Image size 2352x1568 — 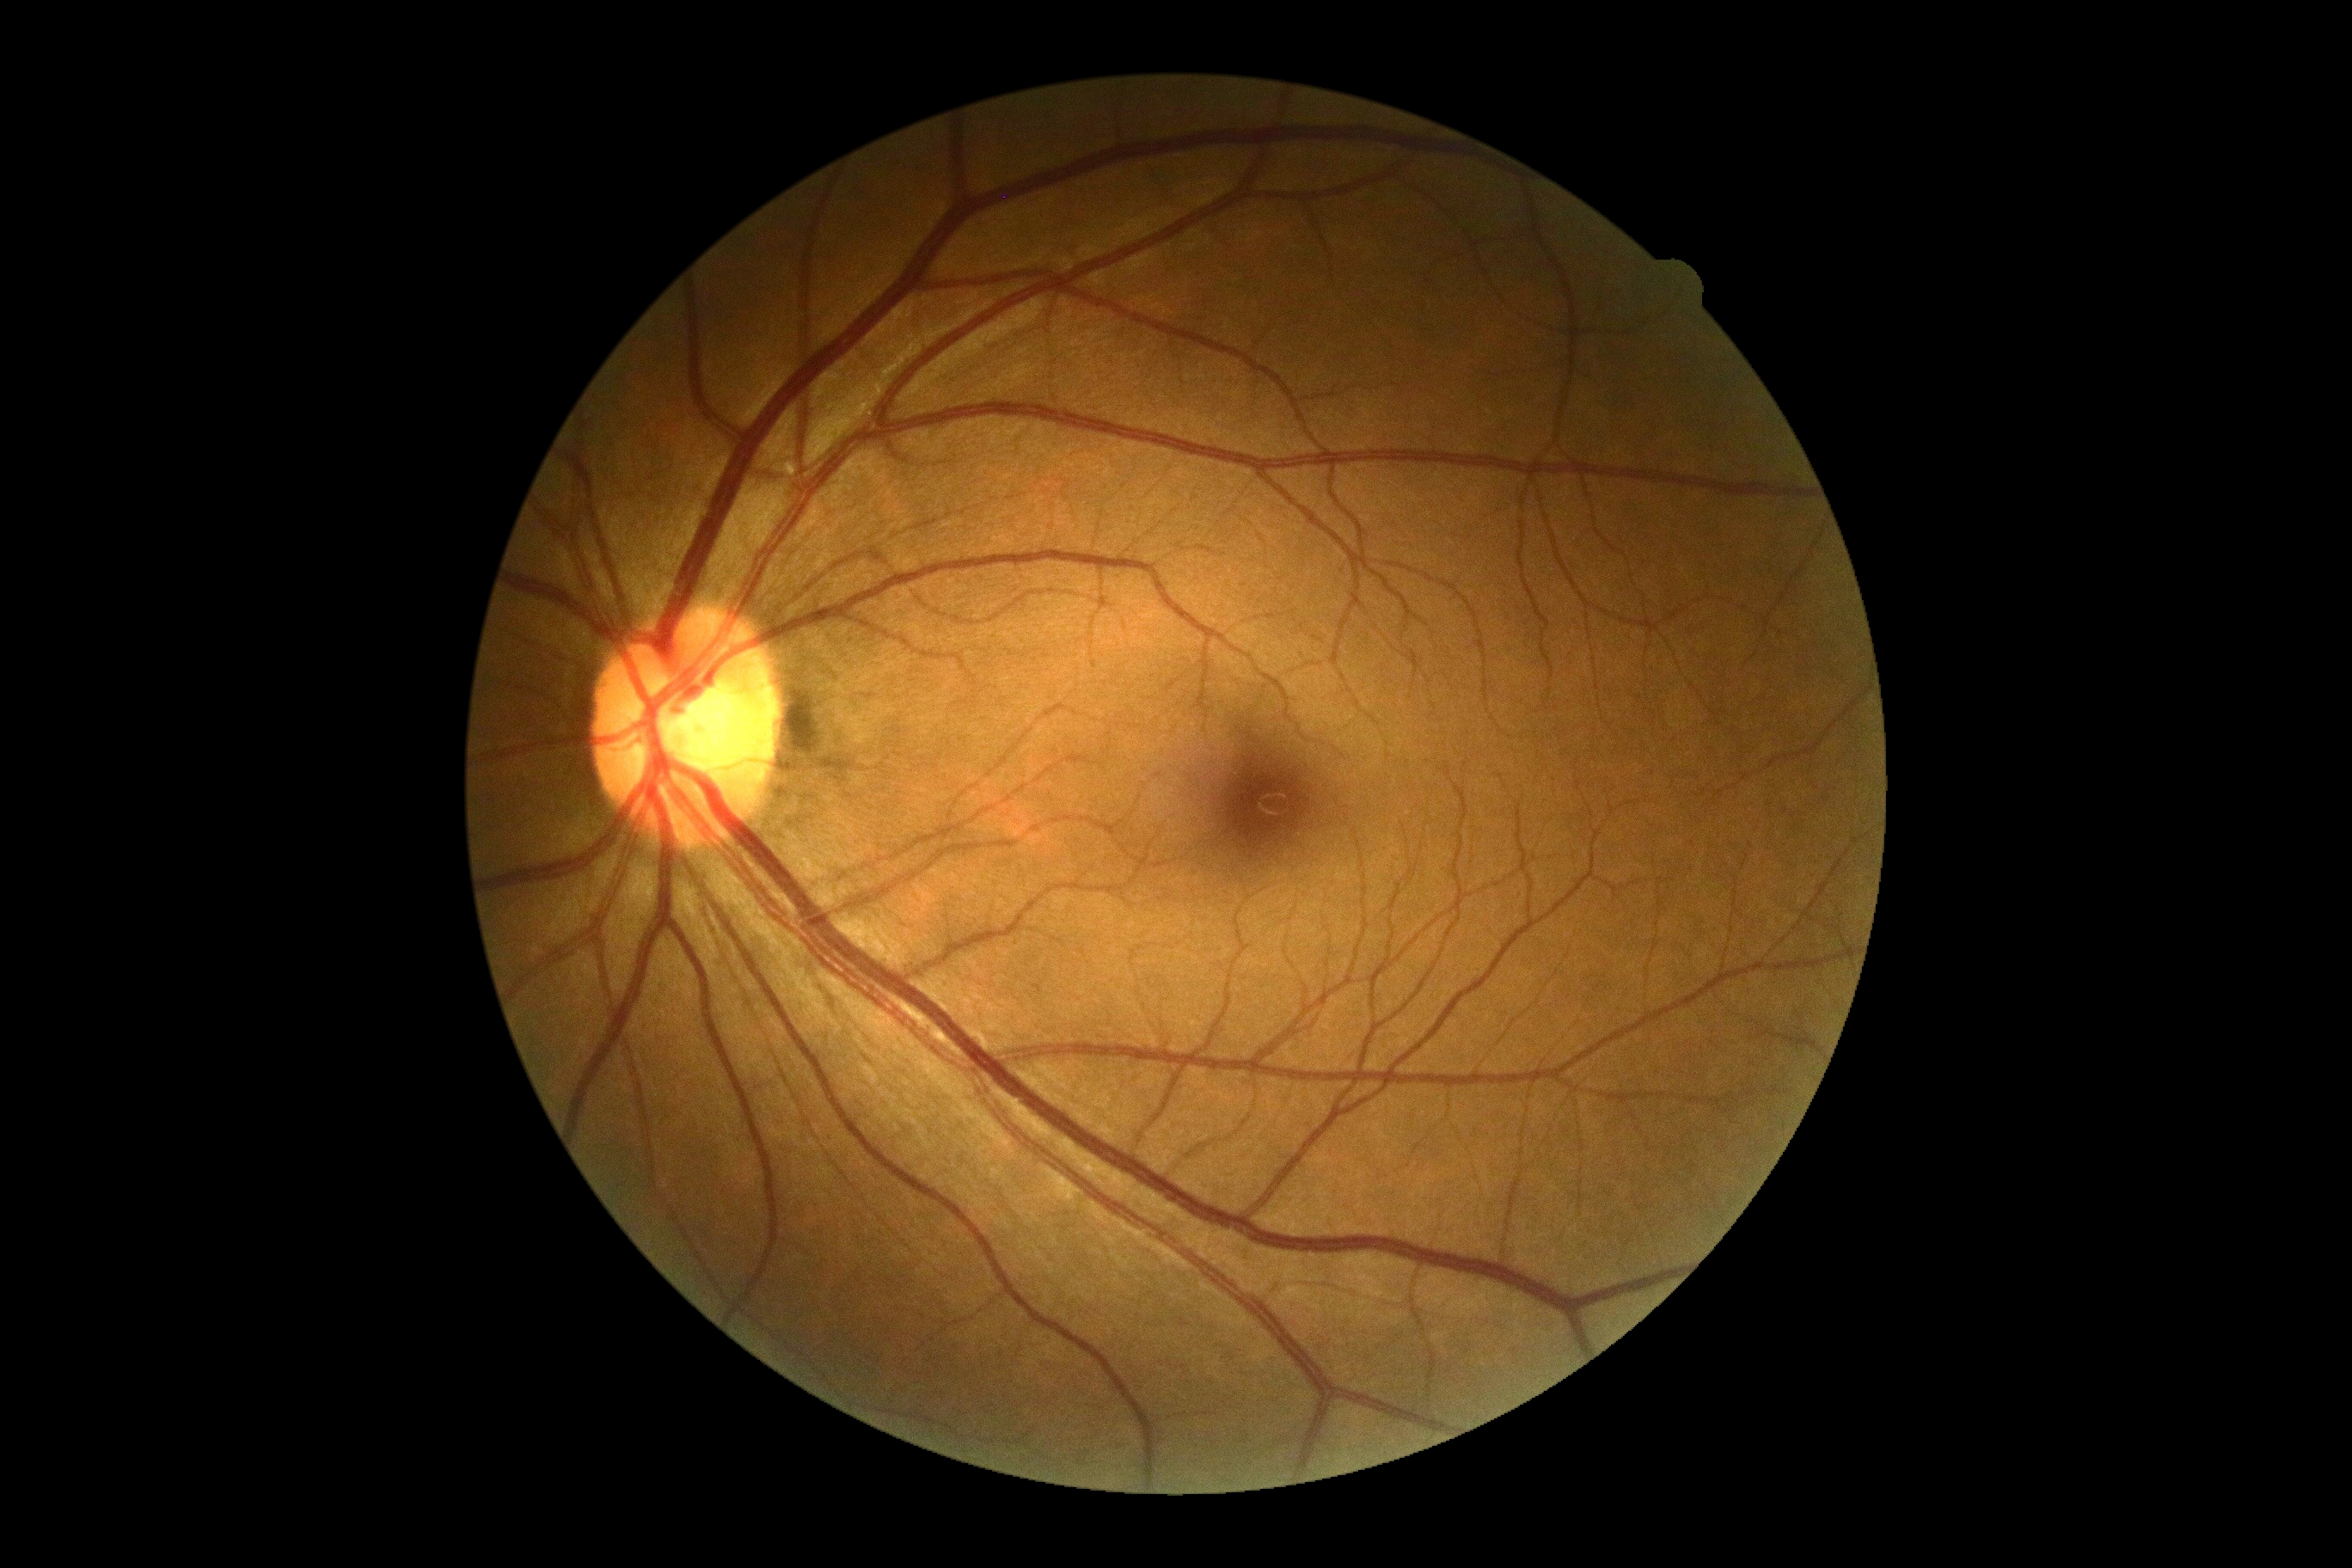

DR grade: no apparent diabetic retinopathy (0) — no visible signs of diabetic retinopathy.